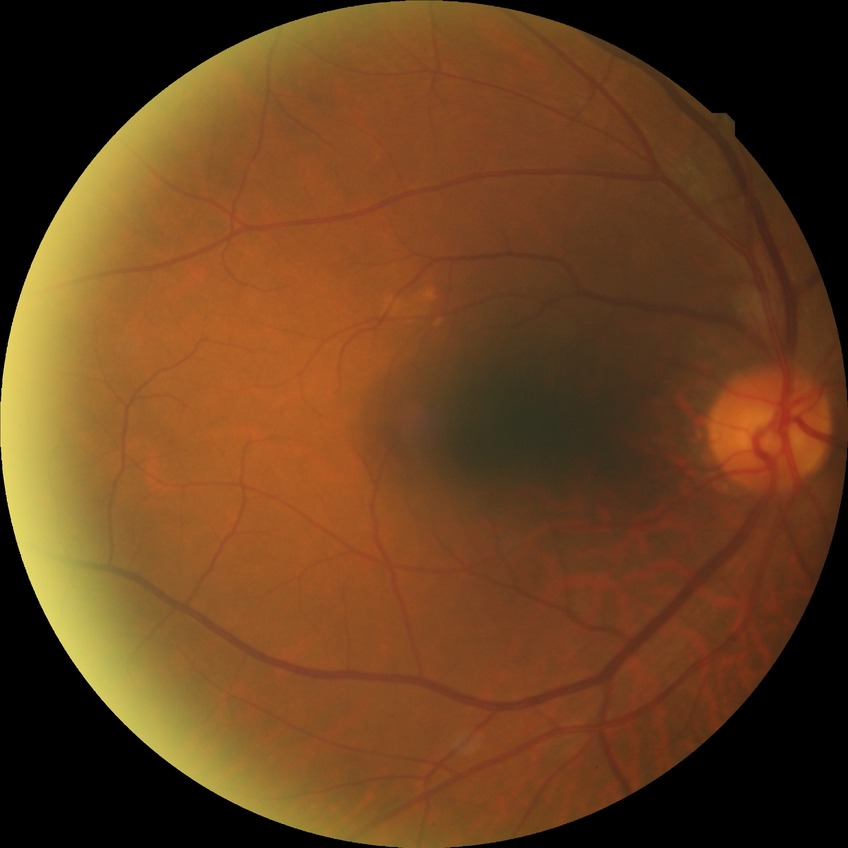

Diabetic retinopathy (DR): no diabetic retinopathy (NDR).